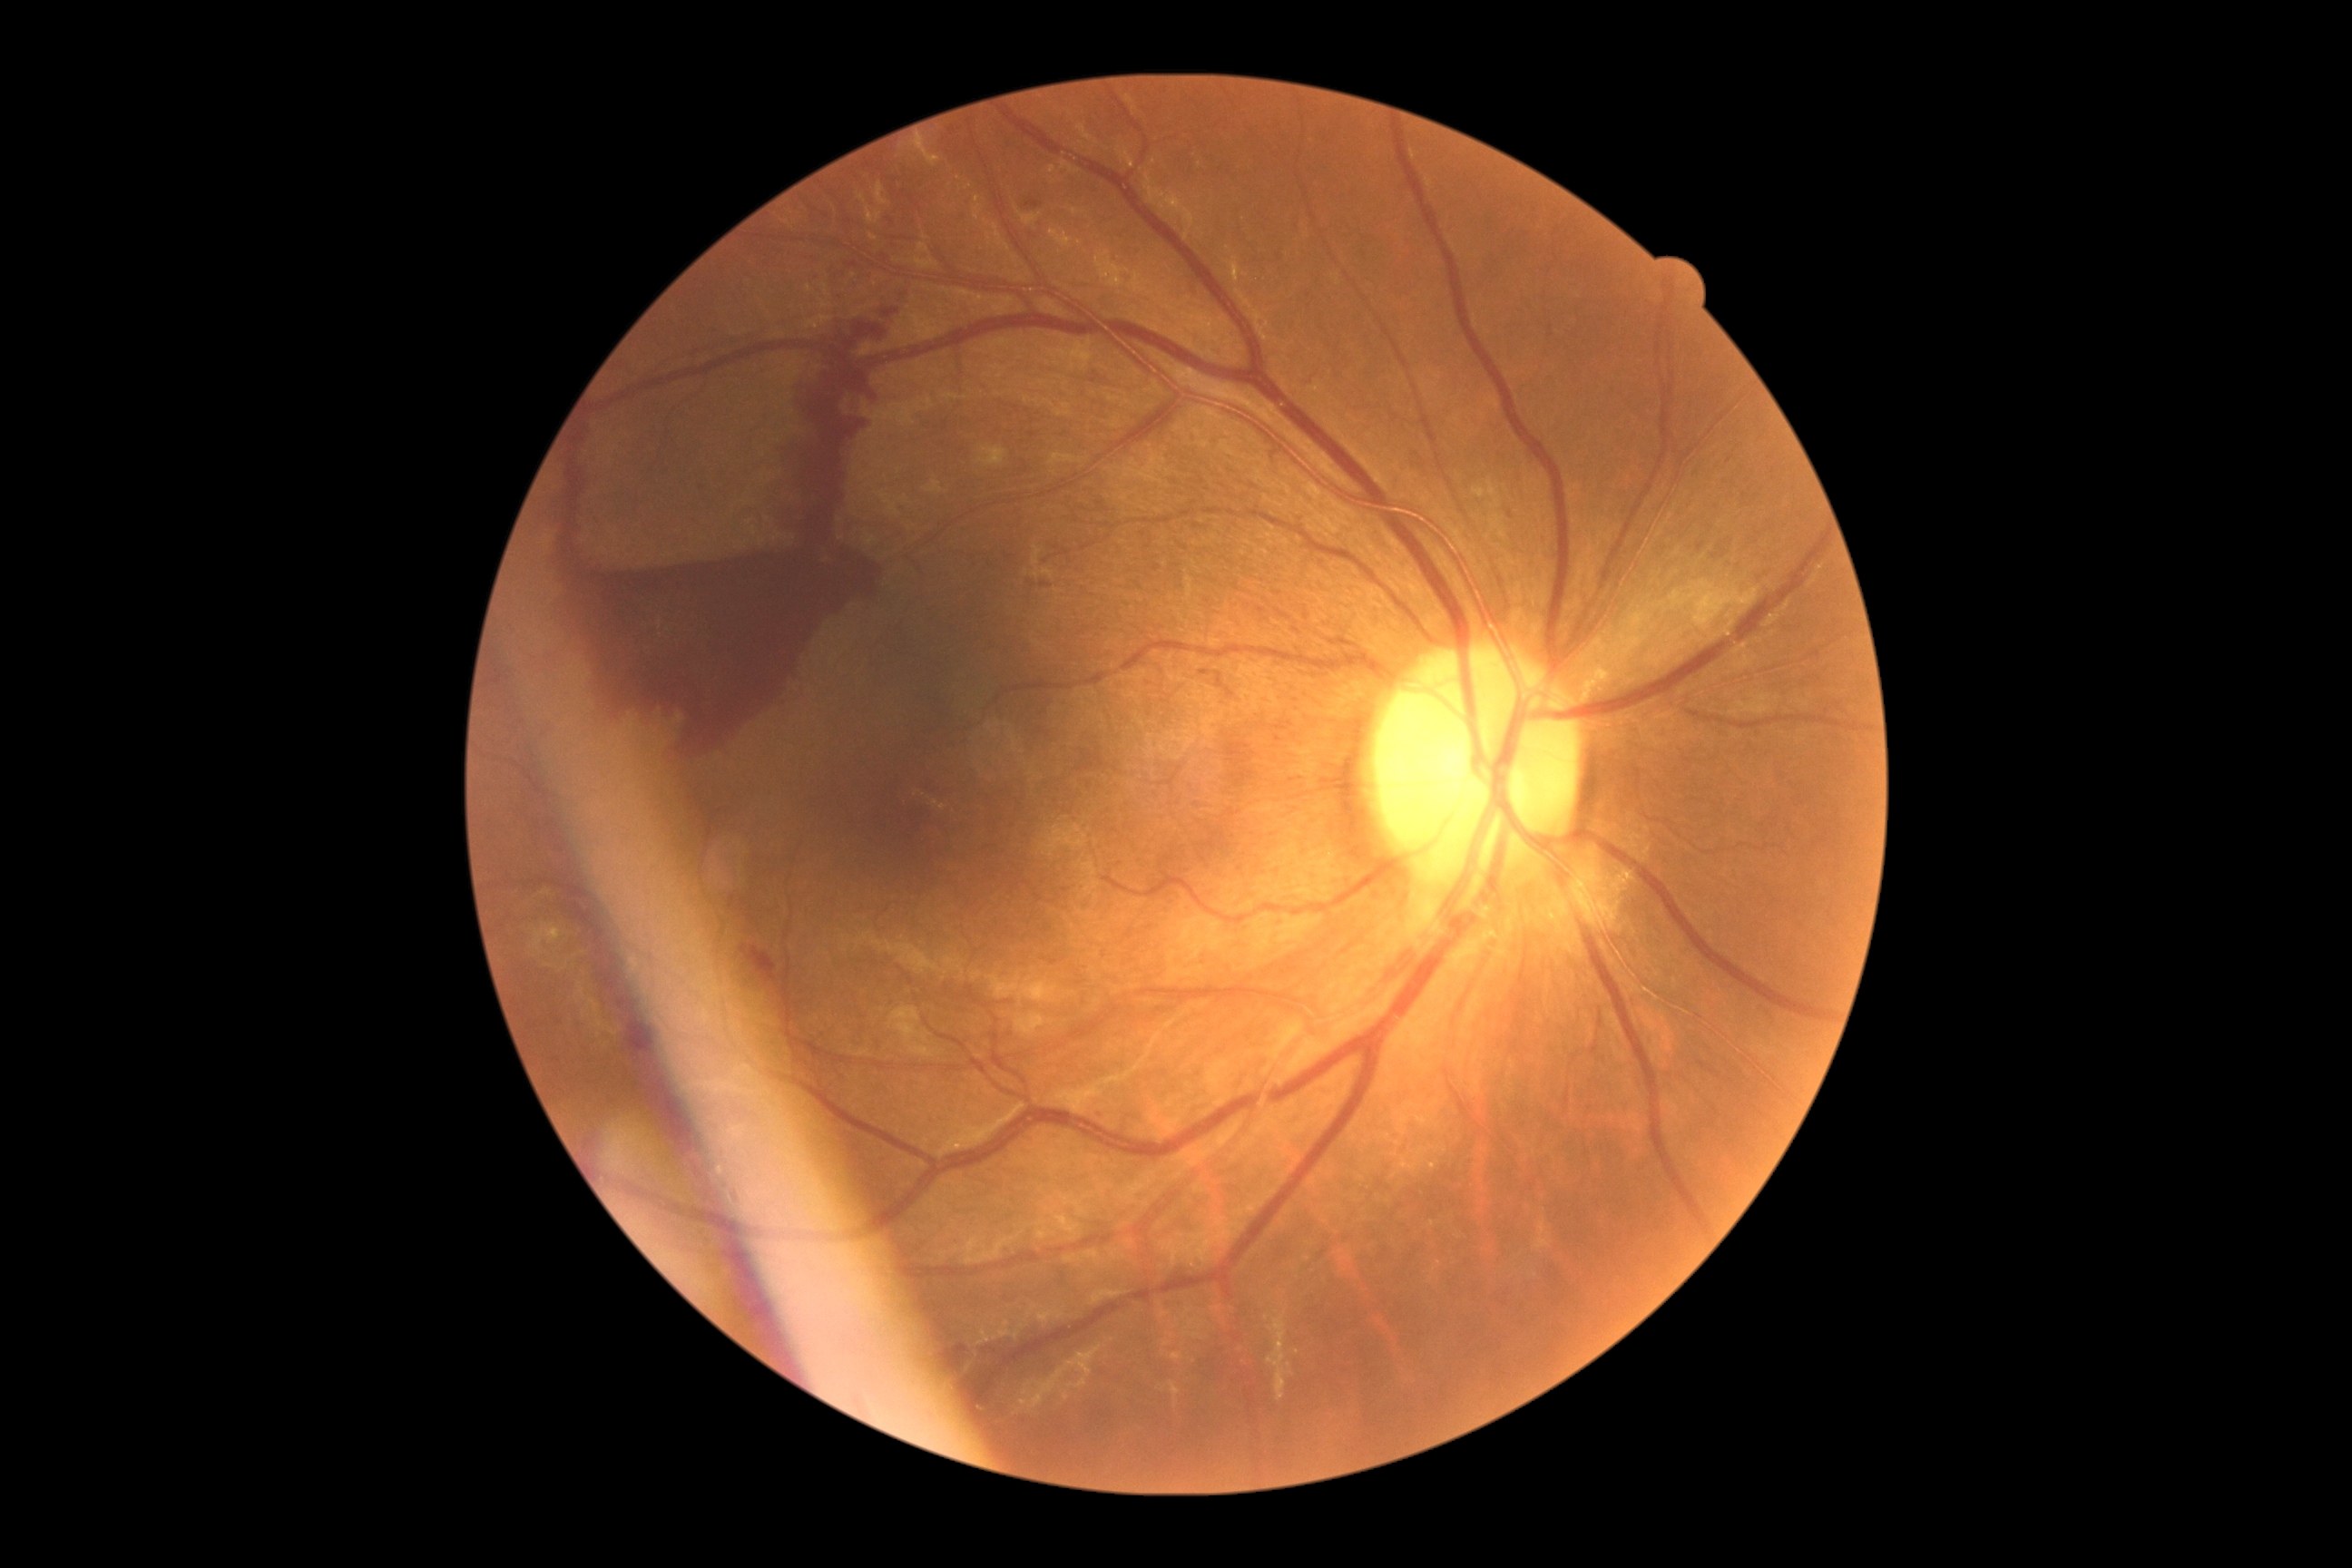

DR class: proliferative diabetic retinopathy.
DR stage is grade 4.